Fundus photo.
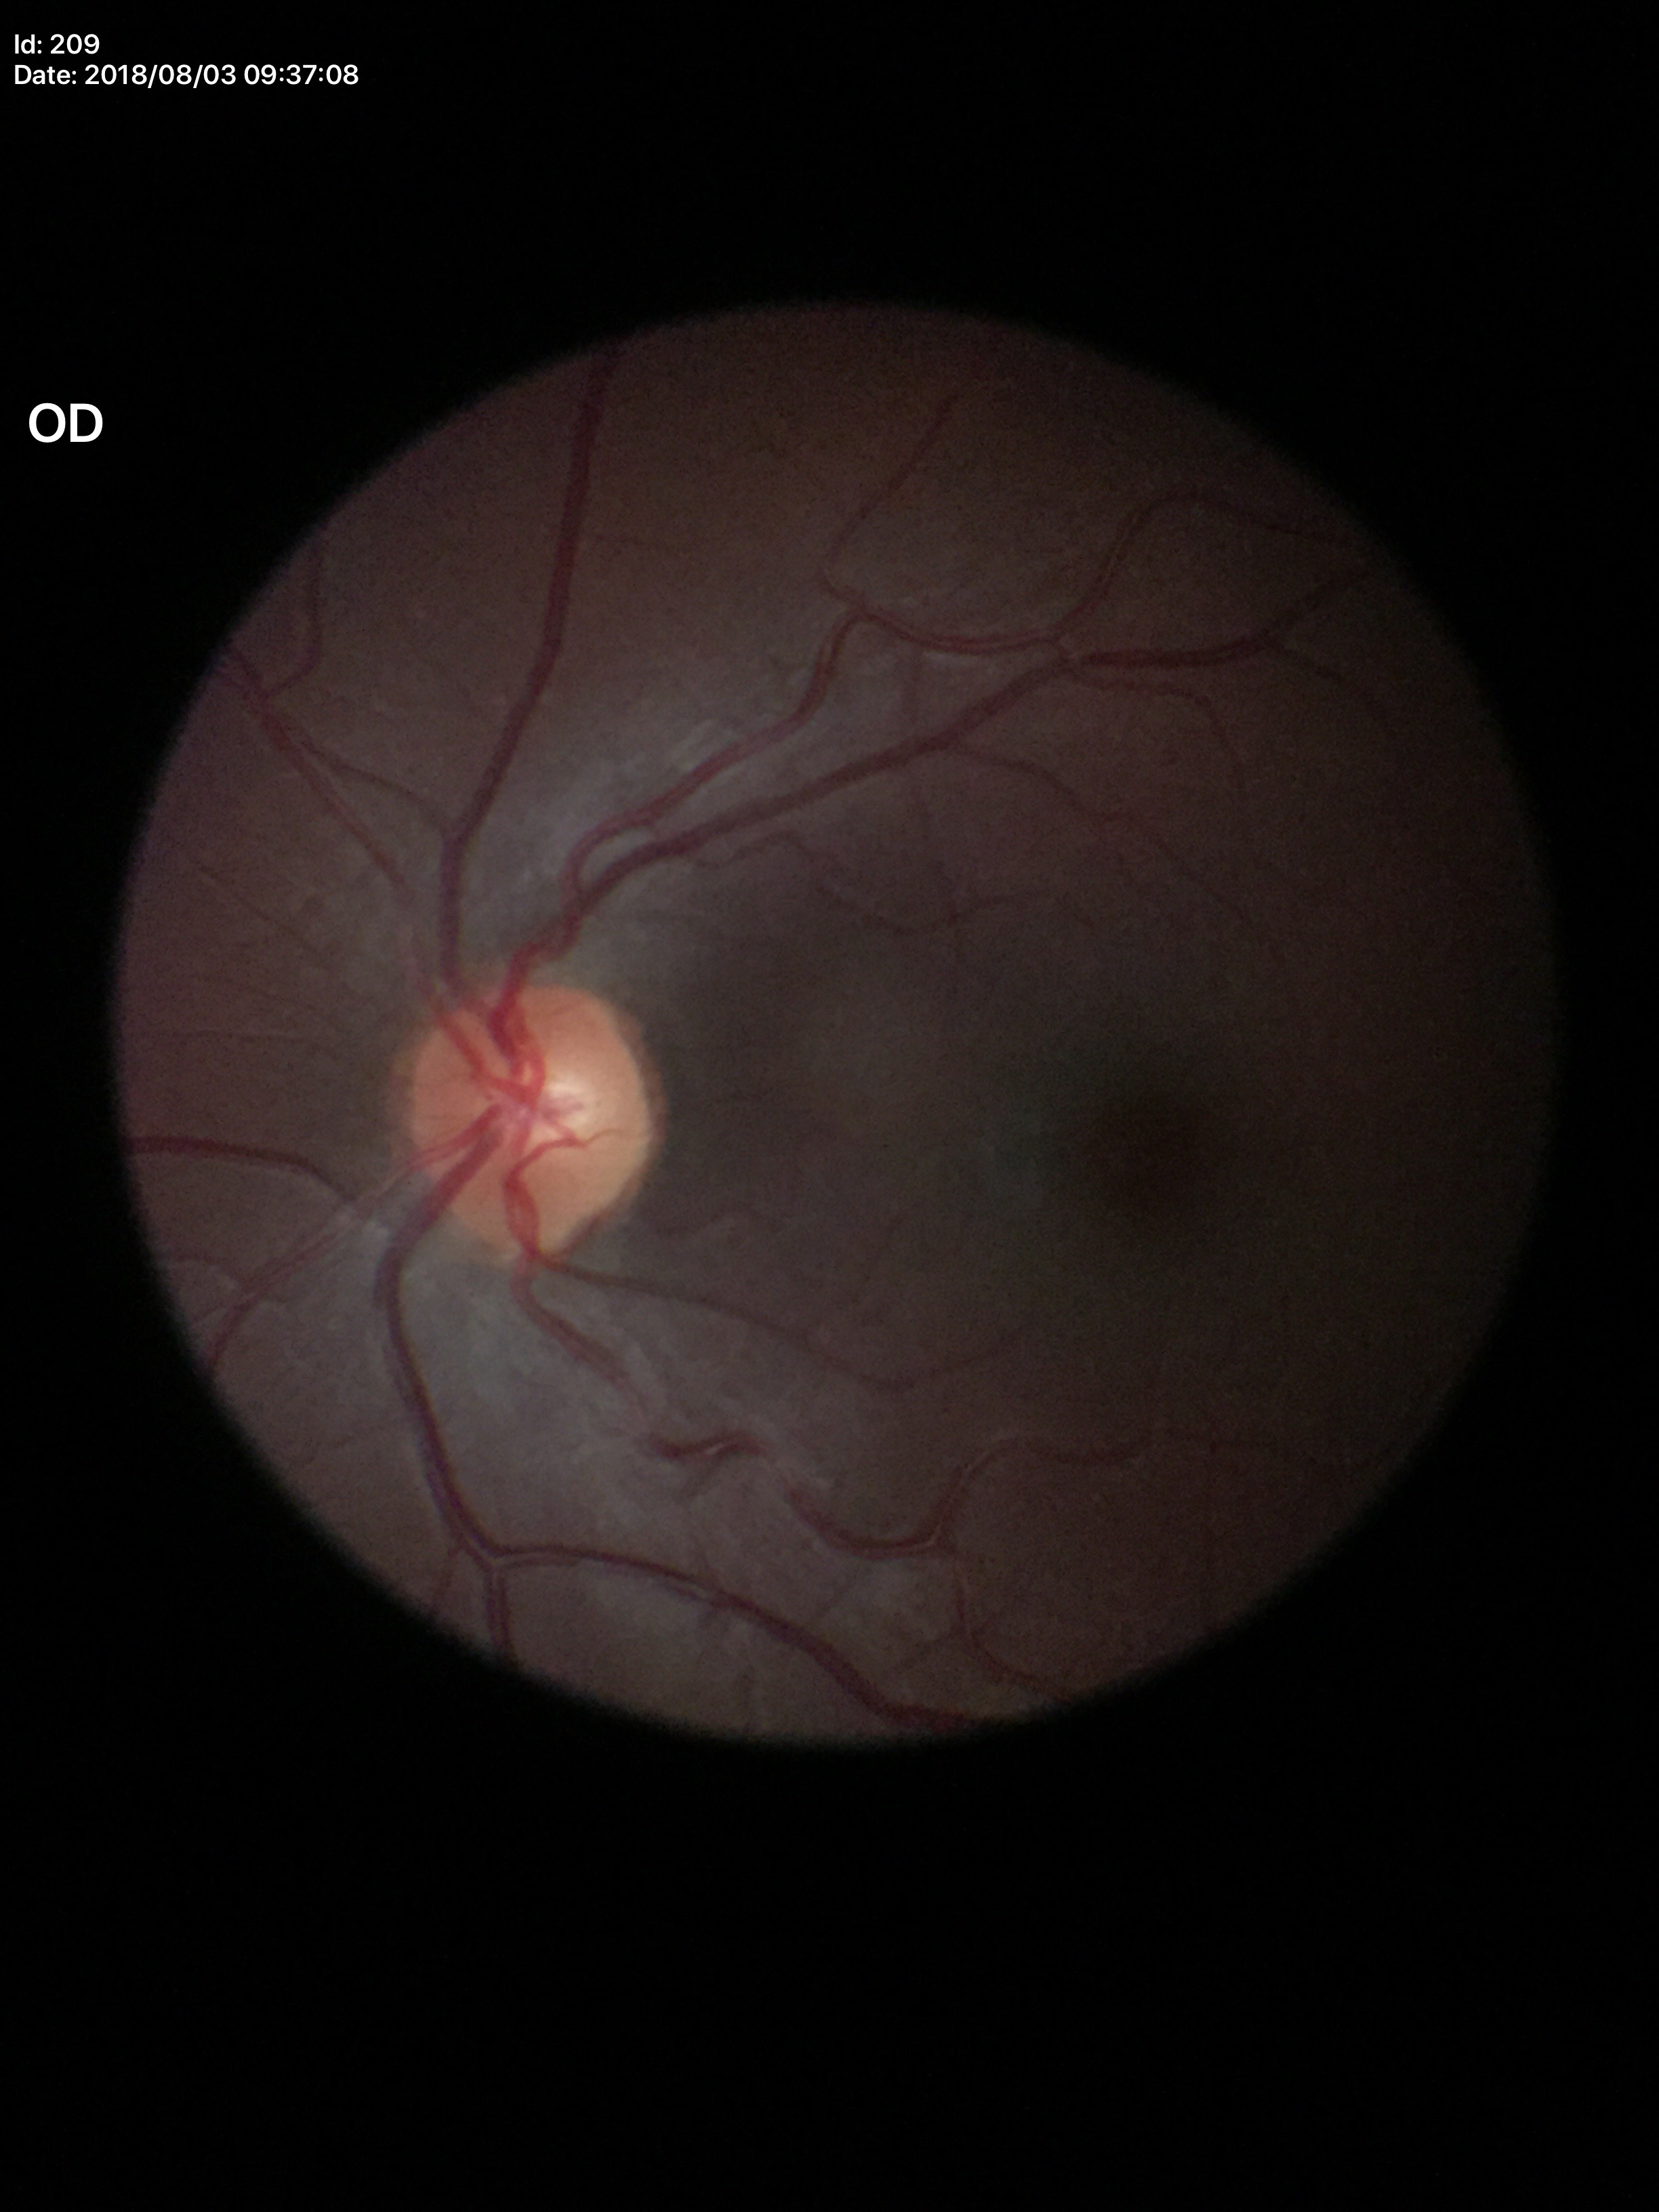
Glaucoma impression = negative
vertical C/D ratio (VCDR) = 0.30